Fundus photo: 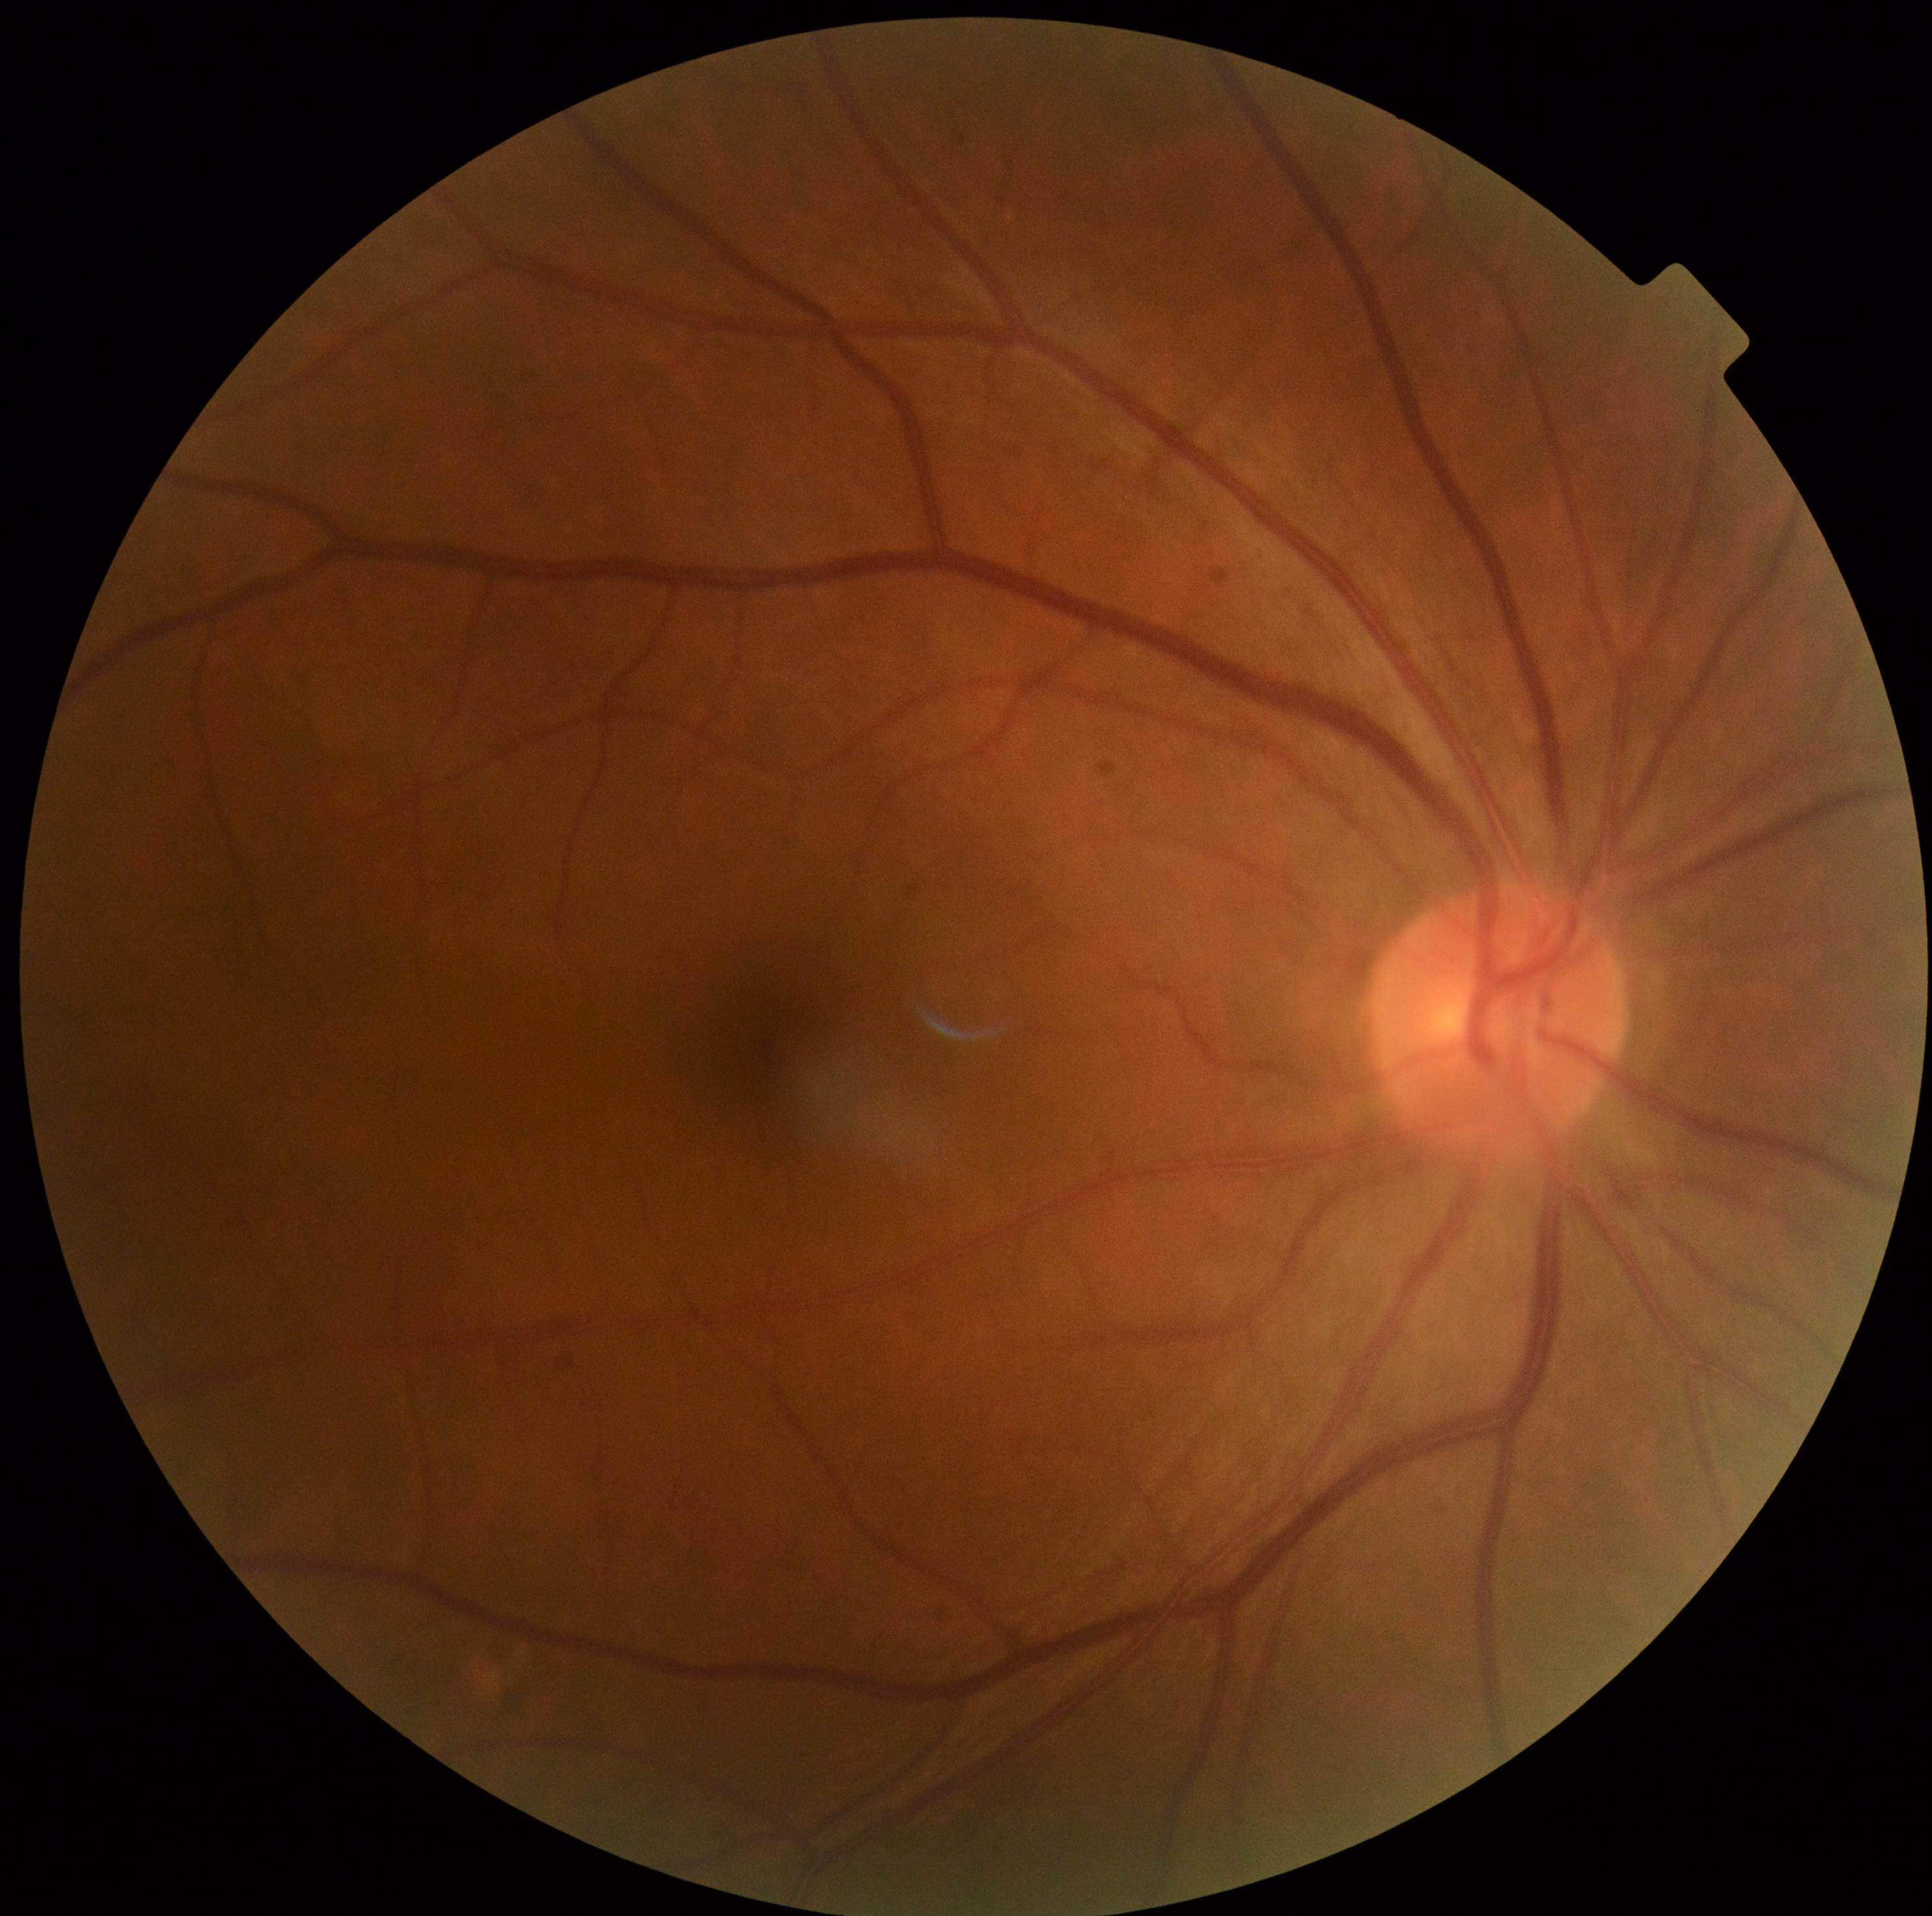
DR severity: 0.